Modified Davis grading
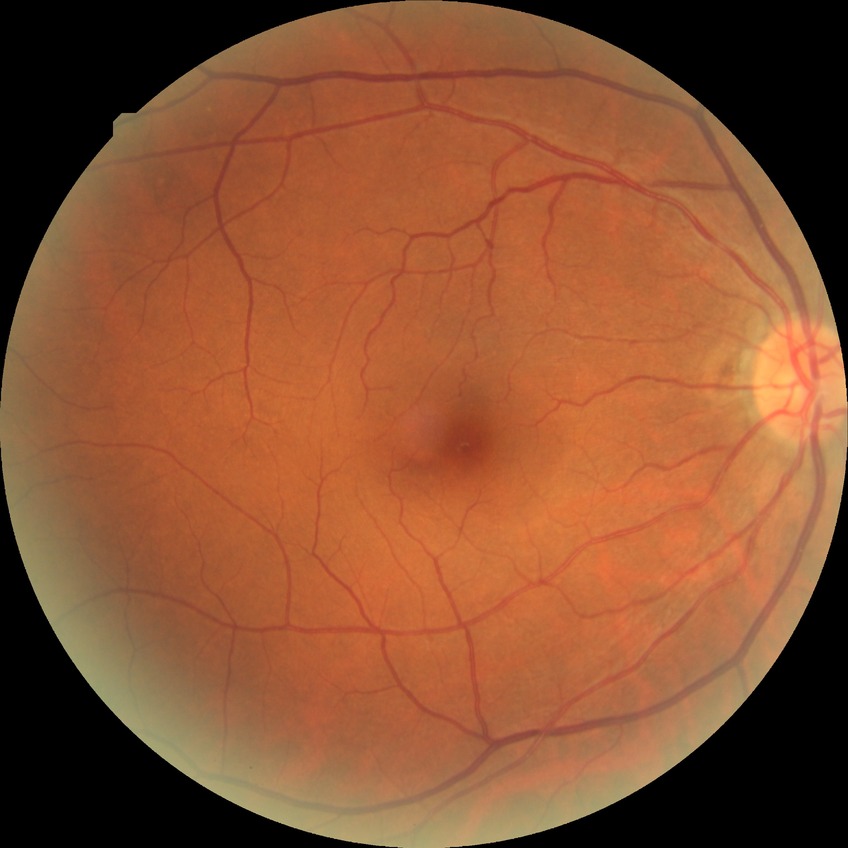

Diabetic retinopathy (DR) is NDR (no diabetic retinopathy).